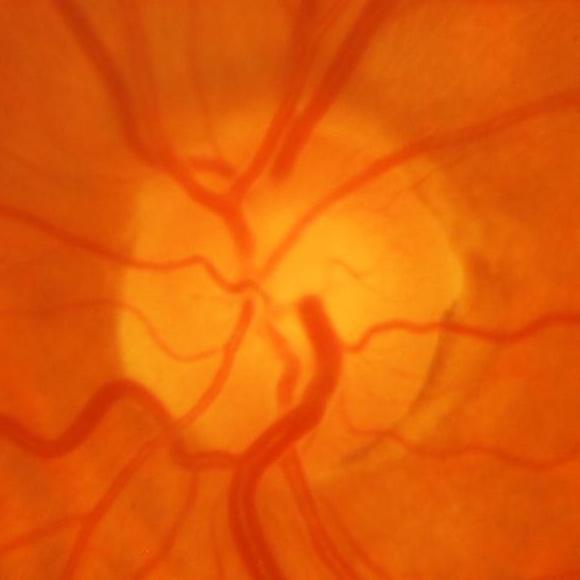 Diagnosis = glaucomatous damage to the optic nerve.